768x576
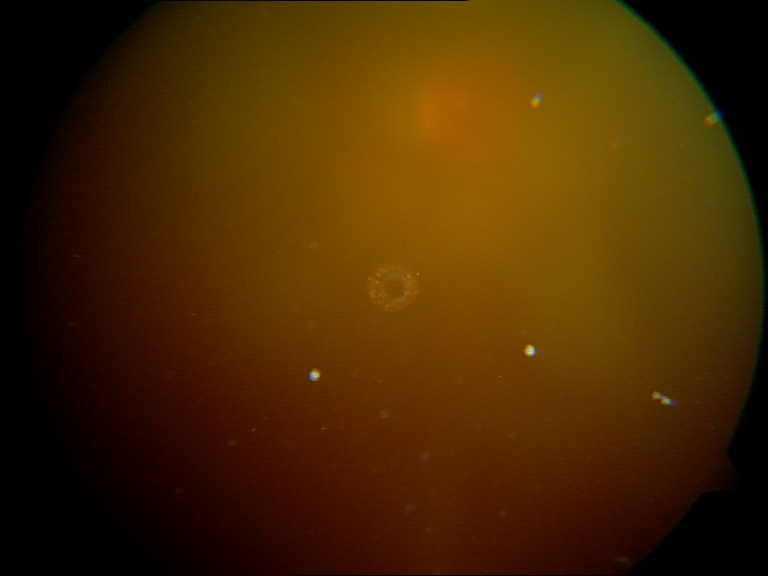
Blurred fundus image with substantial obscuration of retinal landmarks. No evidence of proliferative diabetic retinopathy.